Remidio smartphone fundus camera · color fundus photograph · 1659x2212px: 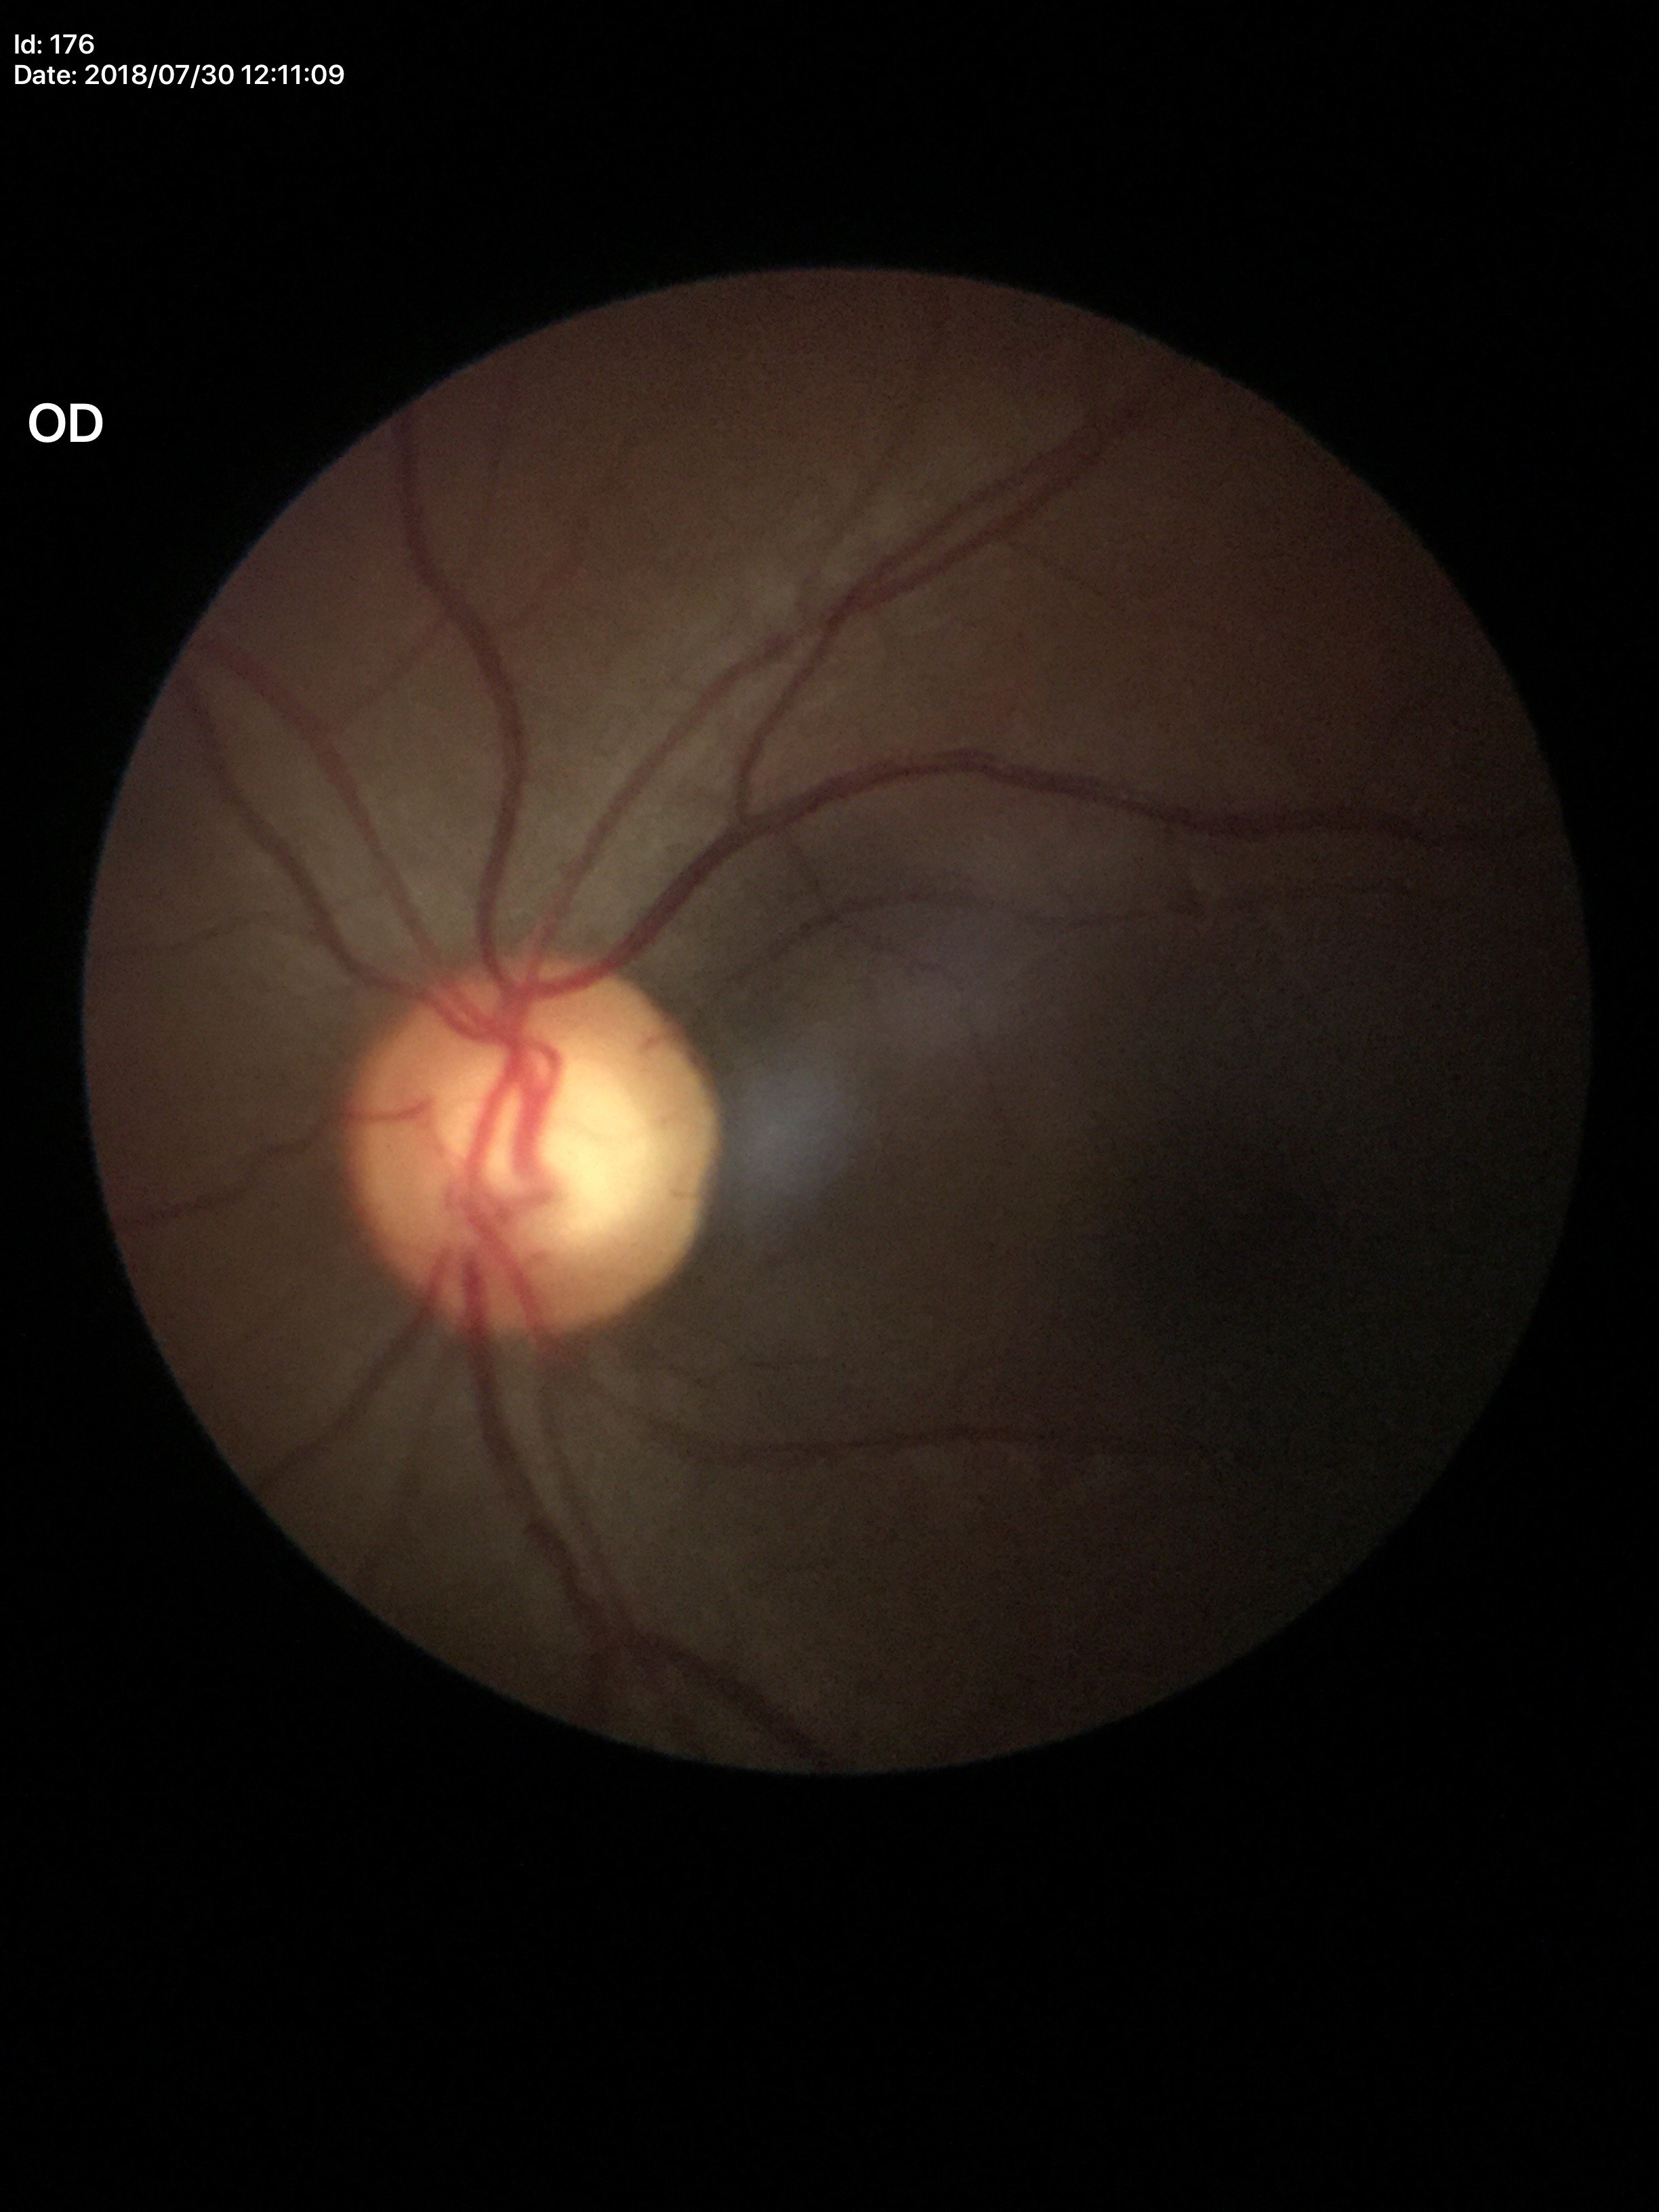
Vertical C/D ratio: 0.61.
No glaucomatous optic neuropathy.